45° FOV: 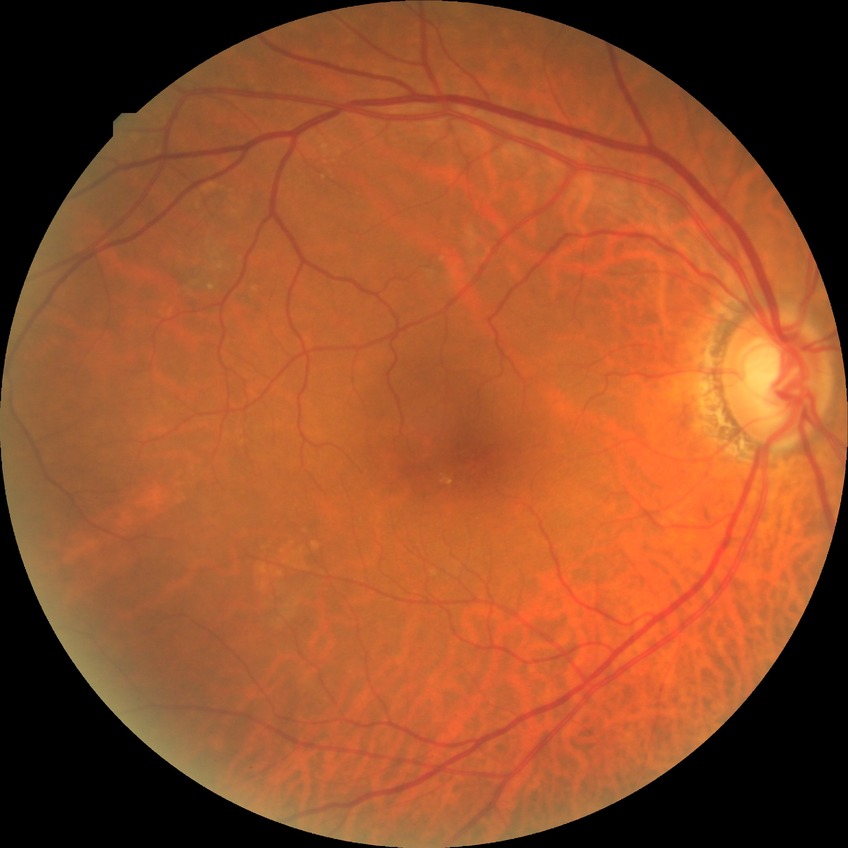 DR severity@NDR.